RetCam wide-field infant fundus image — 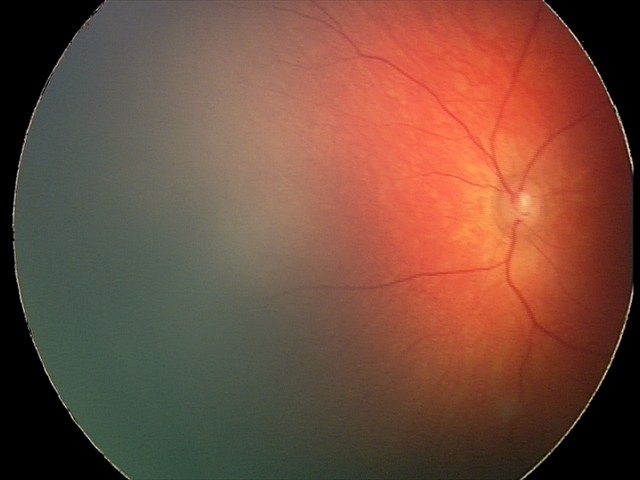 From an examination with diagnosis of retinal hemorrhages.